Pediatric wide-field fundus photograph:
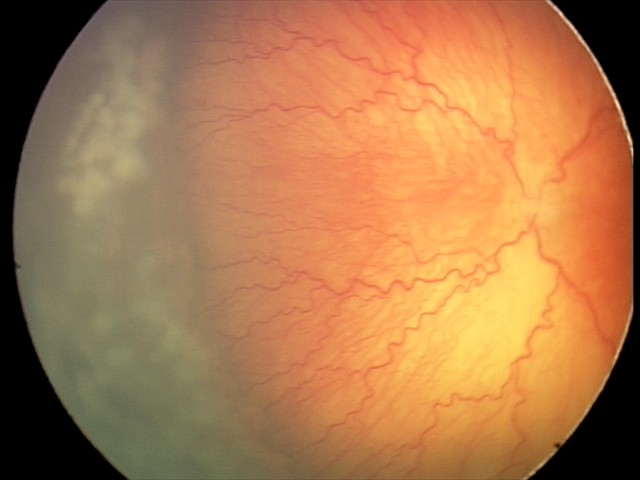

Plus disease was diagnosed.
Examination diagnosed as aggressive retinopathy of prematurity (A-ROP).